FOV: 45 degrees · fundus photo · 2352x1568: 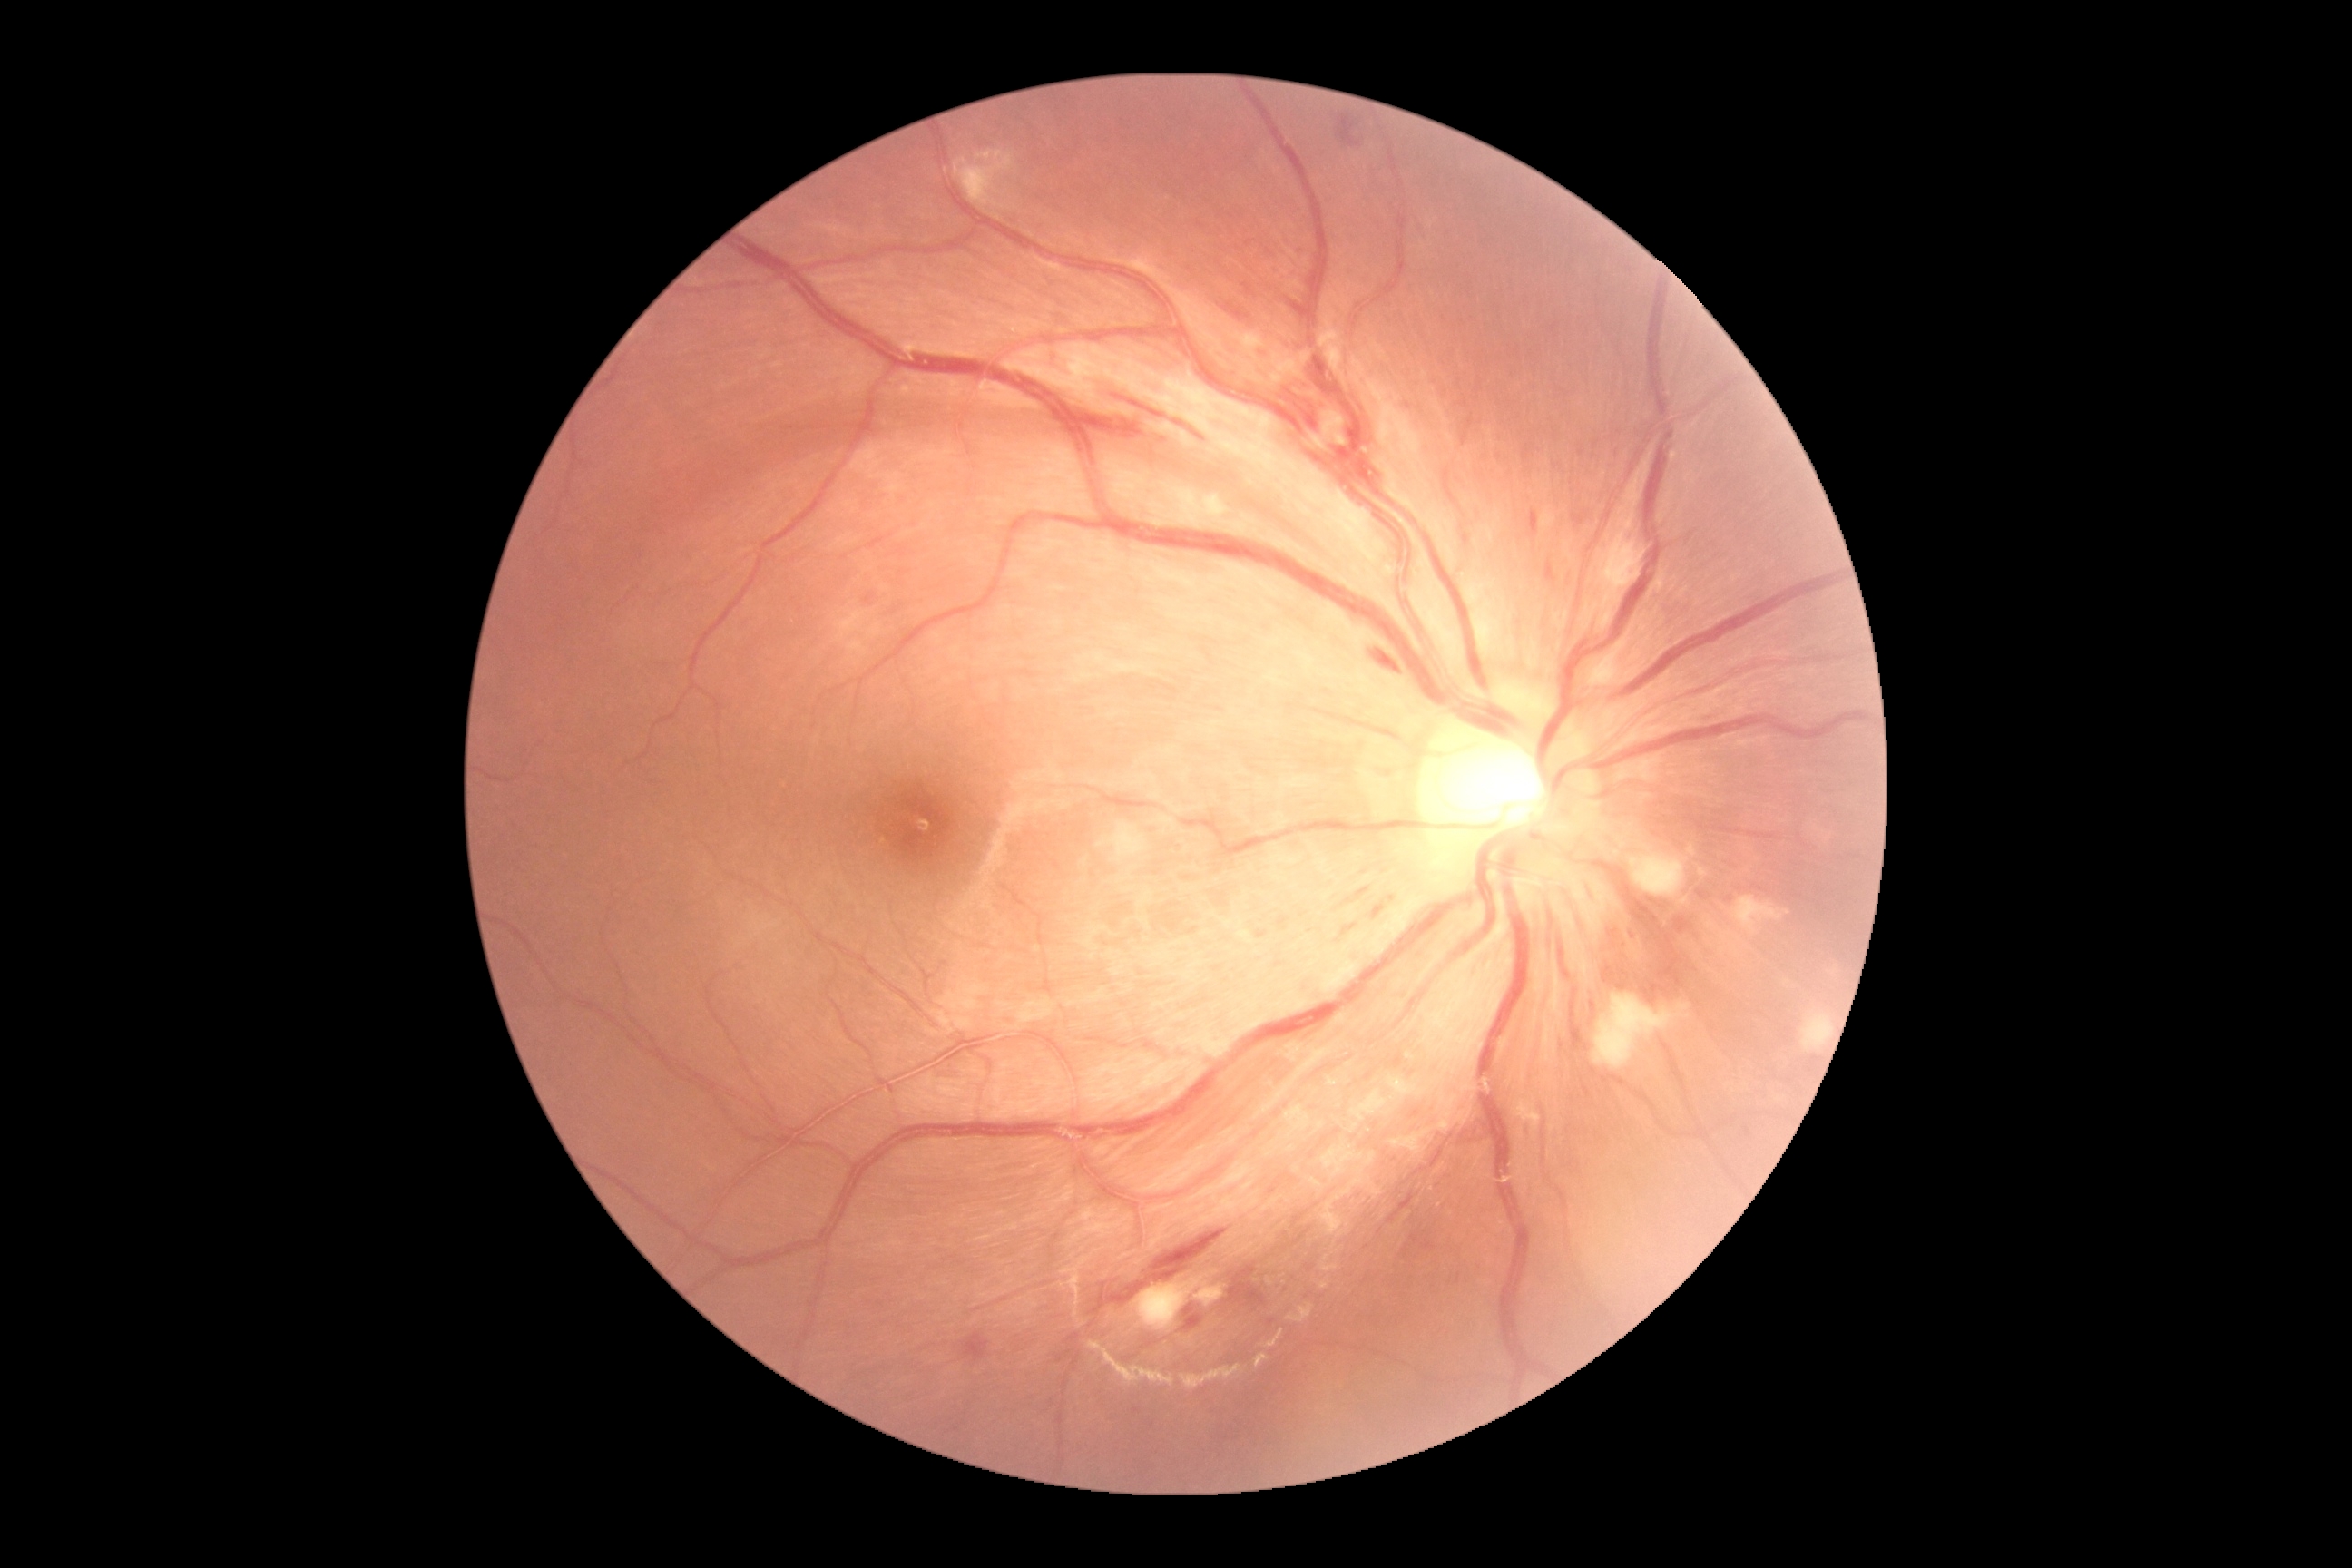

DR grade = 2 (moderate NPDR)